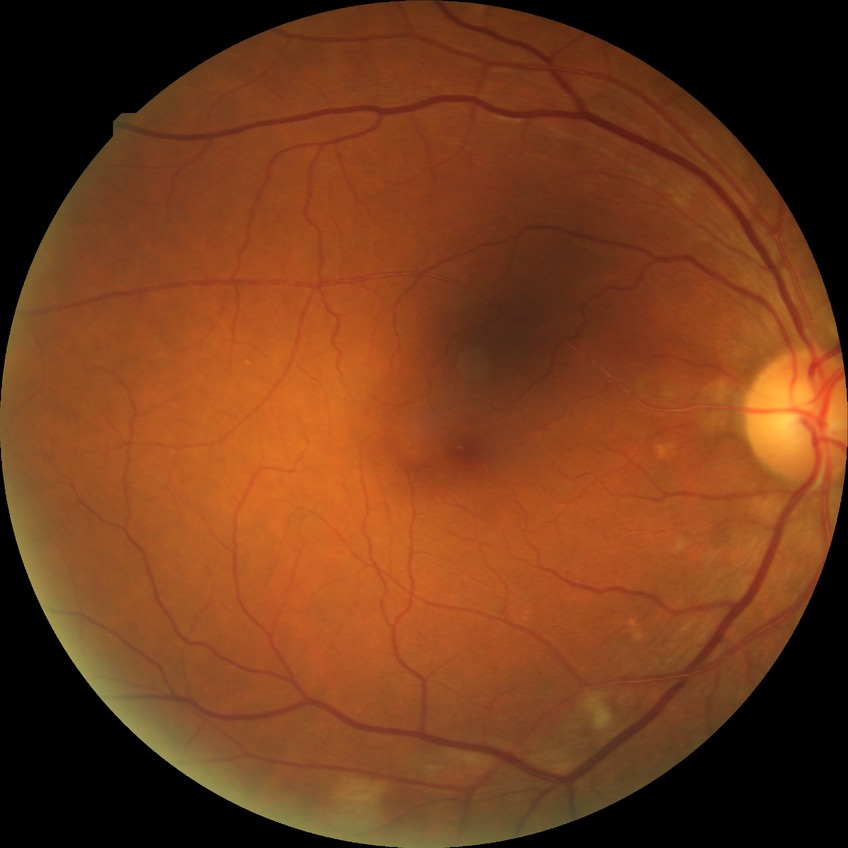
Diabetic retinopathy (DR) is PPDR (pre-proliferative diabetic retinopathy).